2352 by 1568 pixels. Fundus photo. Captured on a Canon CR-1 fundus camera:
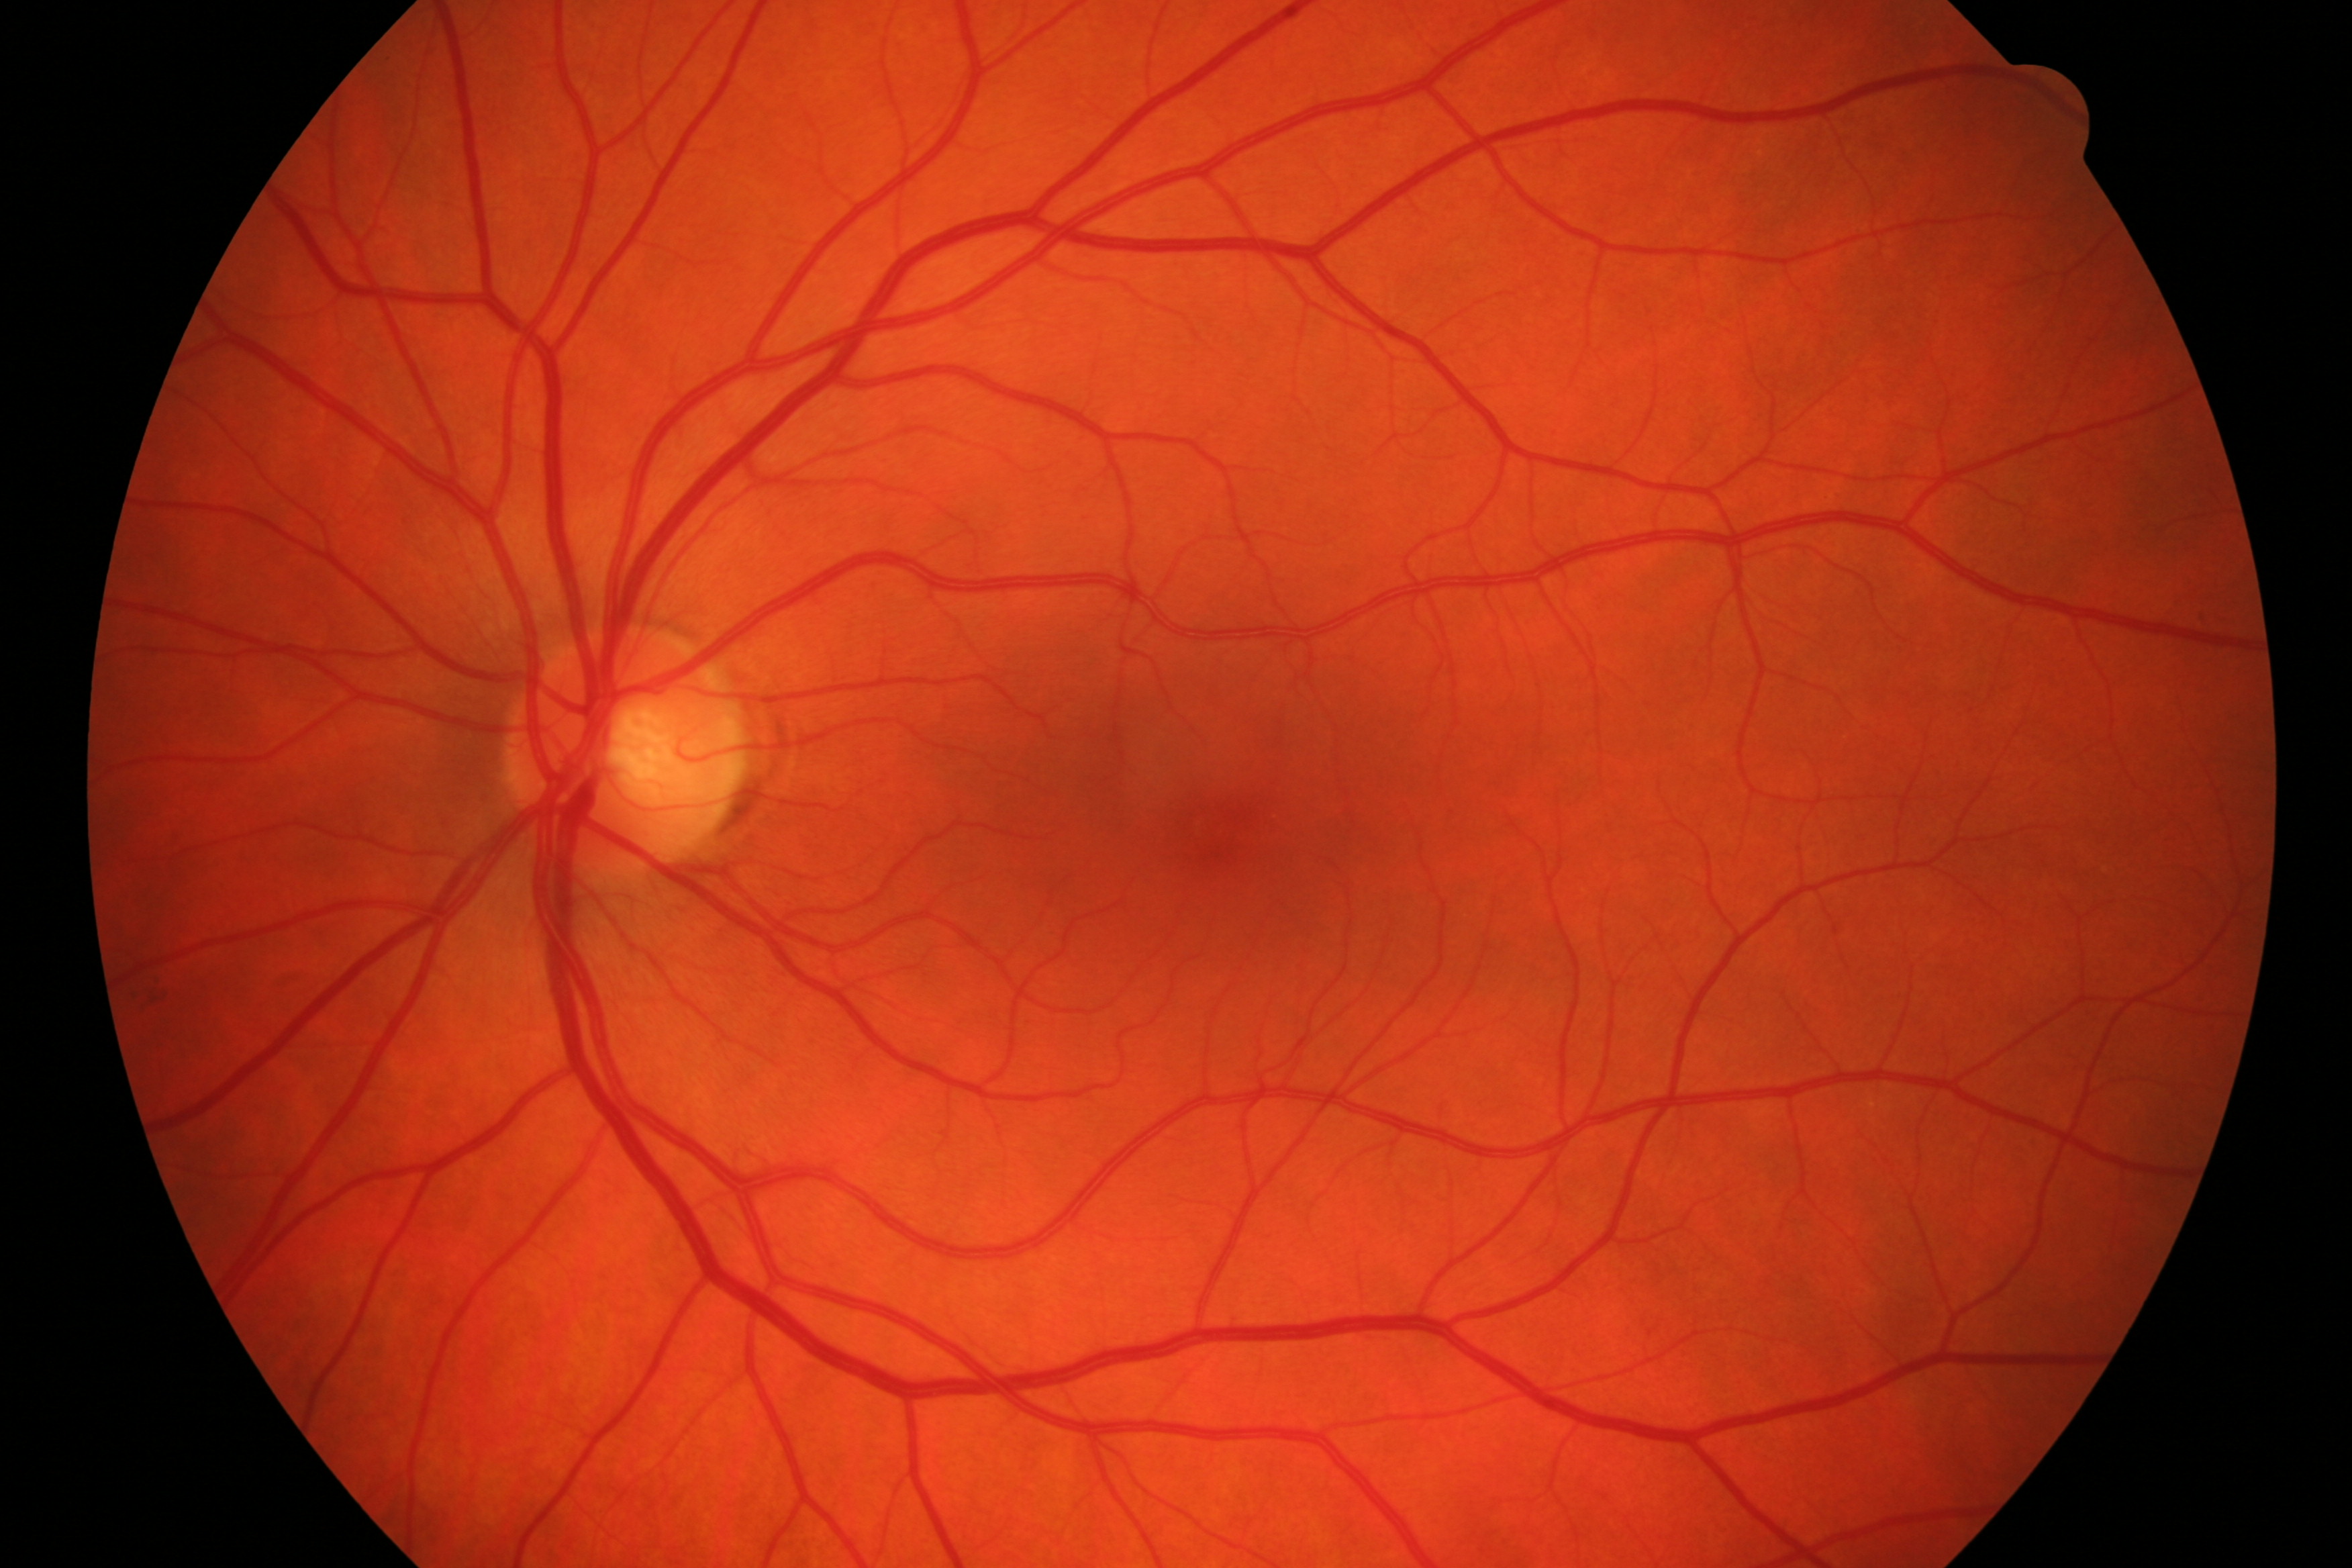
Impression: no evidence of DR or glaucoma.